1240 by 1240 pixels · pediatric wide-field fundus photograph · Phoenix ICON, 100° FOV: 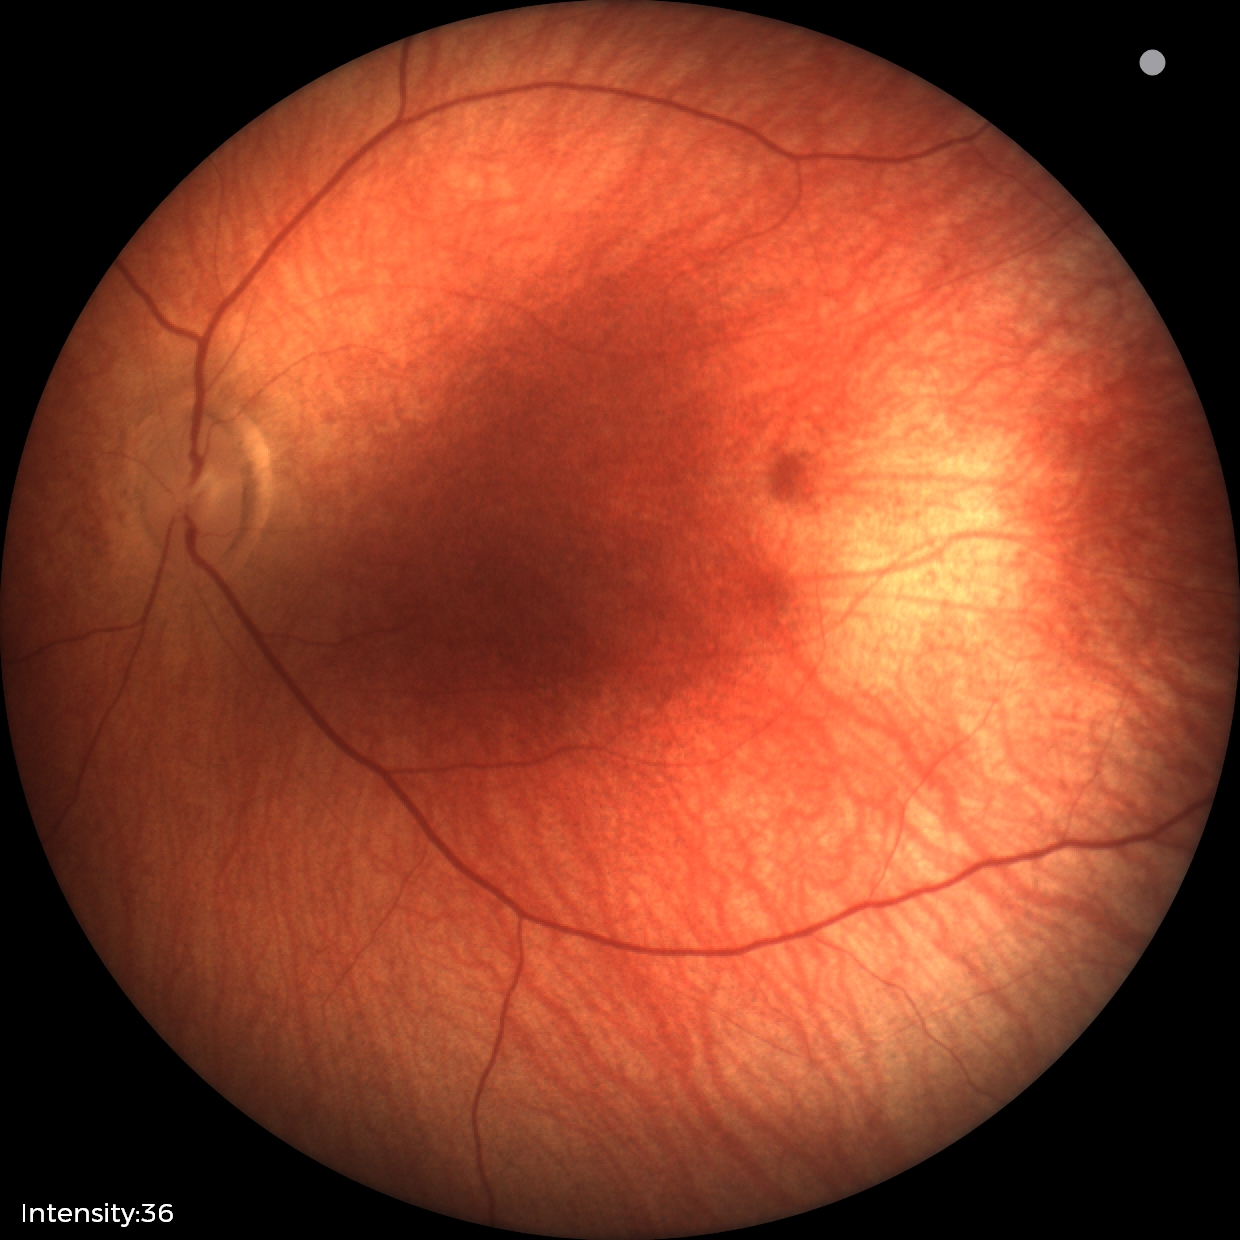 Normal screening examination.